Color fundus image
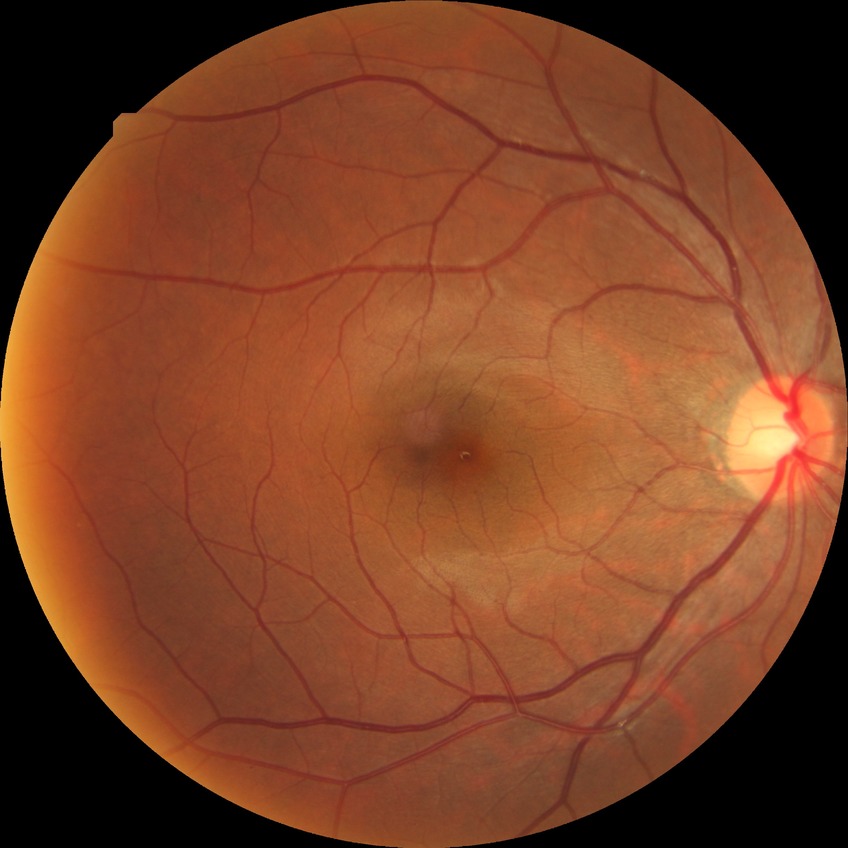

– DR impression — no apparent DR
– Davis DR grade — NDR